Color fundus image — 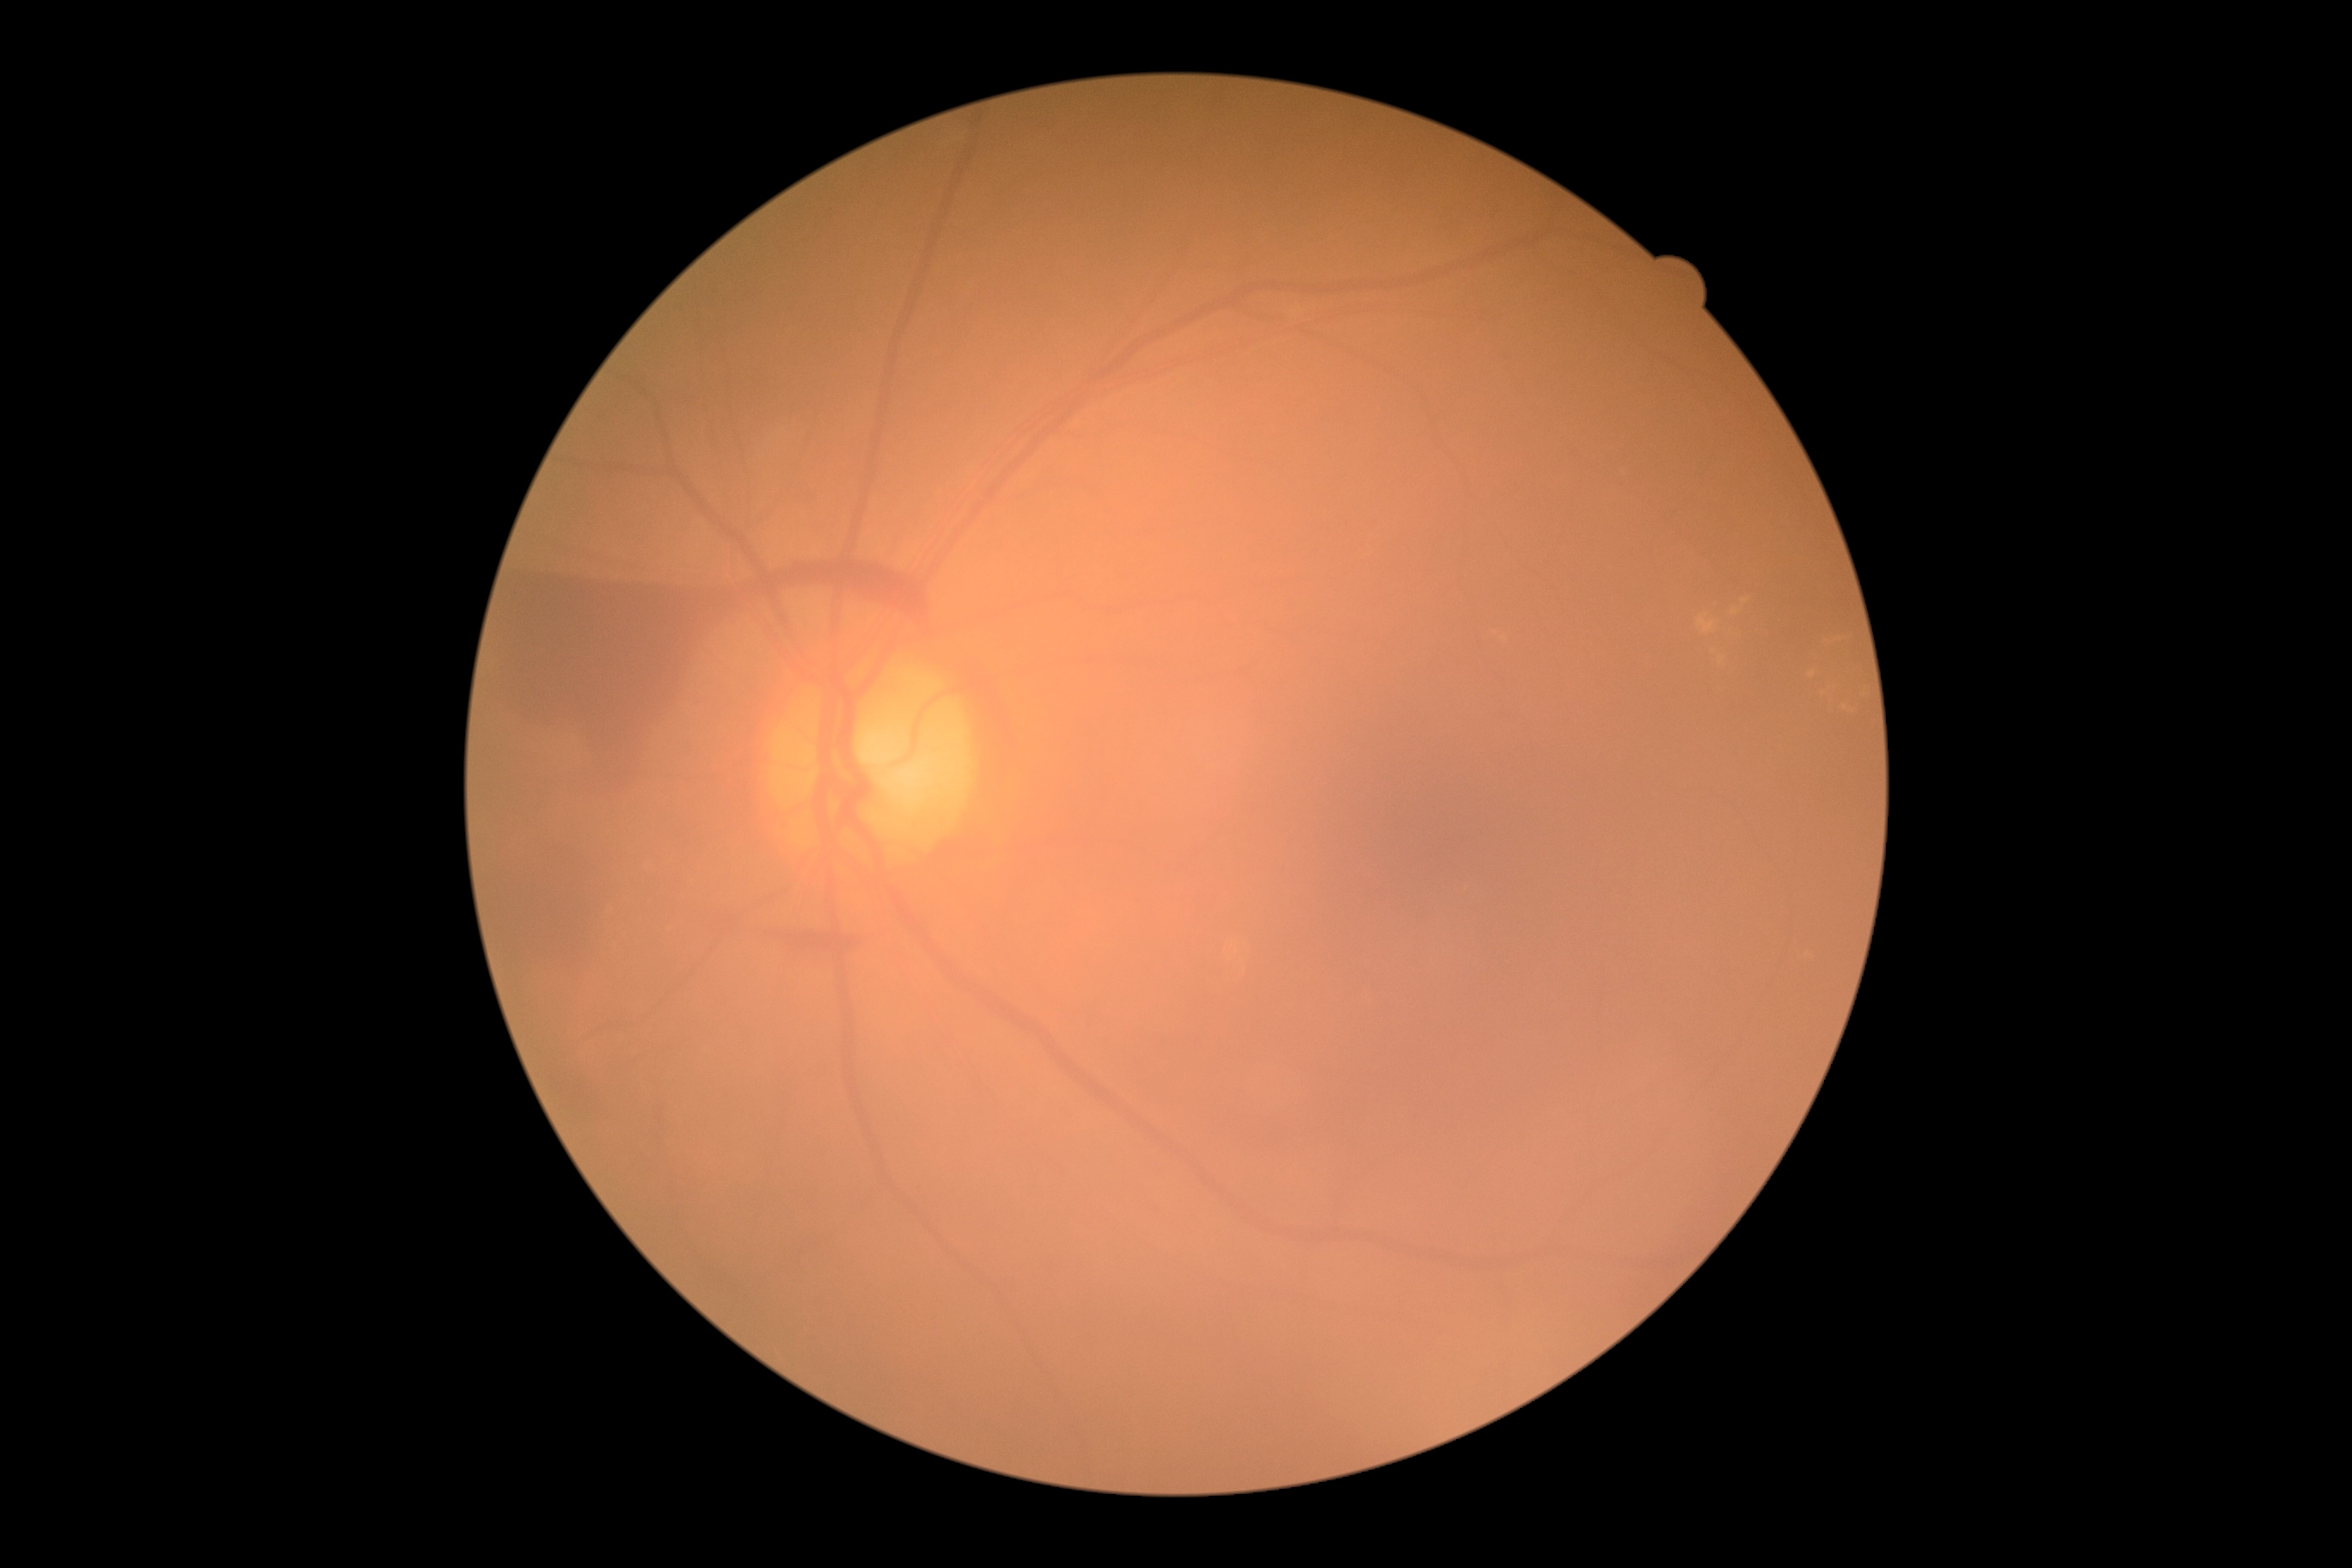 Diabetic retinopathy (DR): grade 4 (PDR).